NIDEK AFC-230; nonmydriatic; posterior pole color fundus photograph; modified Davis grading — 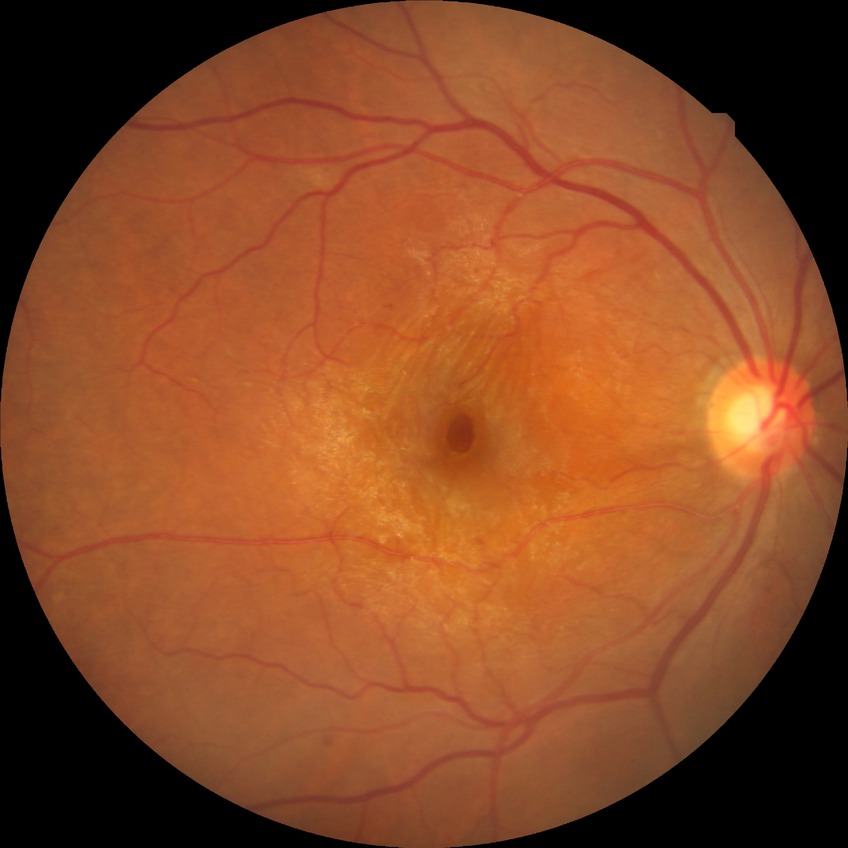

  davis_grade: SDR (simple diabetic retinopathy)